Optic disc region crop. 240x240. Acquired with a Nidek AFC-330: 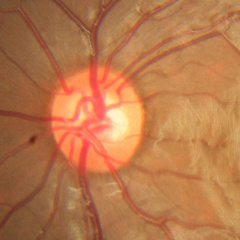
Assessment = no glaucomatous findings.